2102x1736px
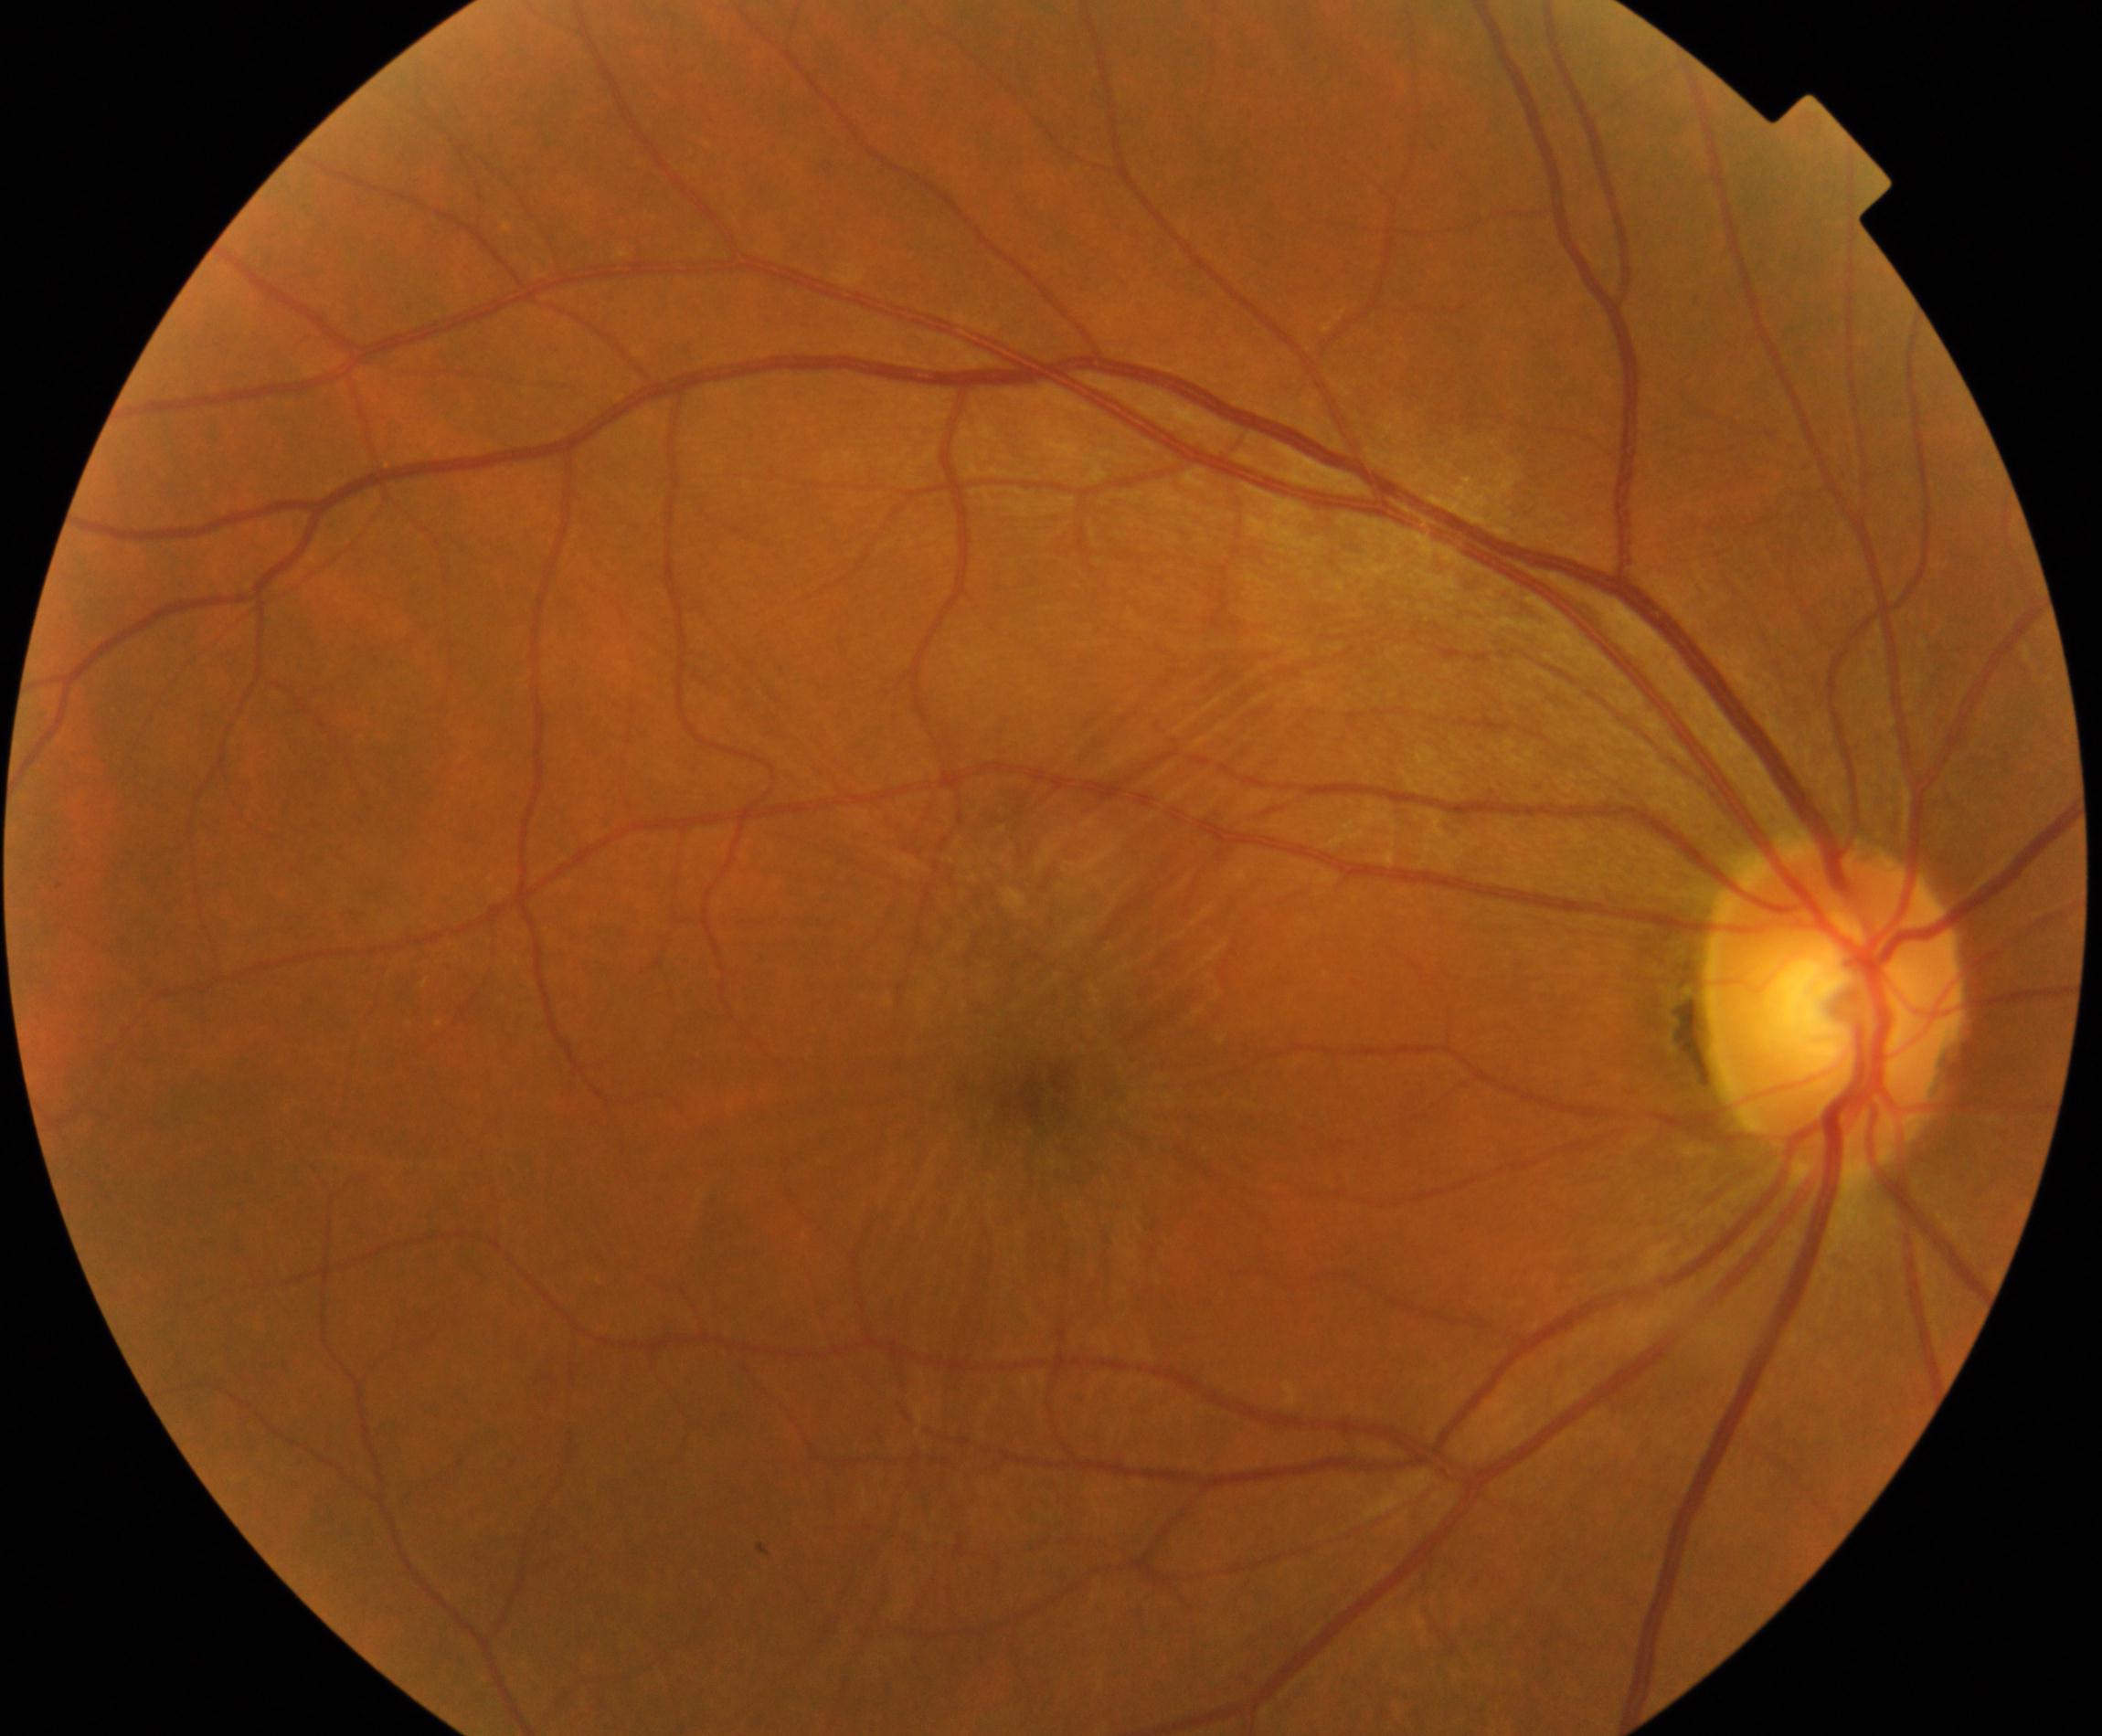
Fundus image consistent with epiretinal membrane.